Clarity RetCam 3, 130° FOV. Wide-field contact fundus photograph of an infant
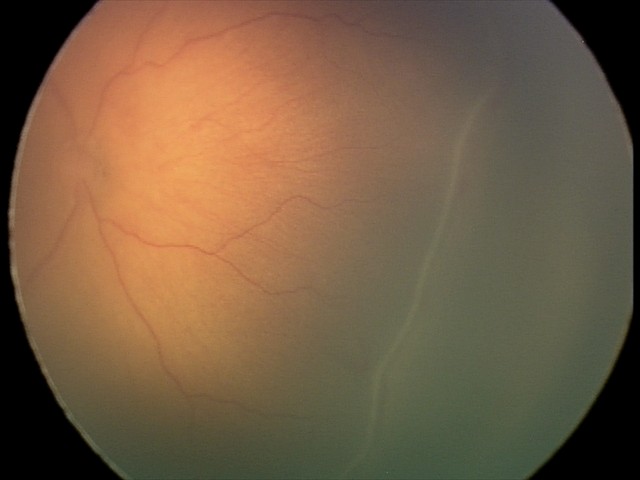
Without plus disease.
Screening series with ROP stage 2 — ridge with height and width at the demarcation line.